Graded on the modified Davis scale:
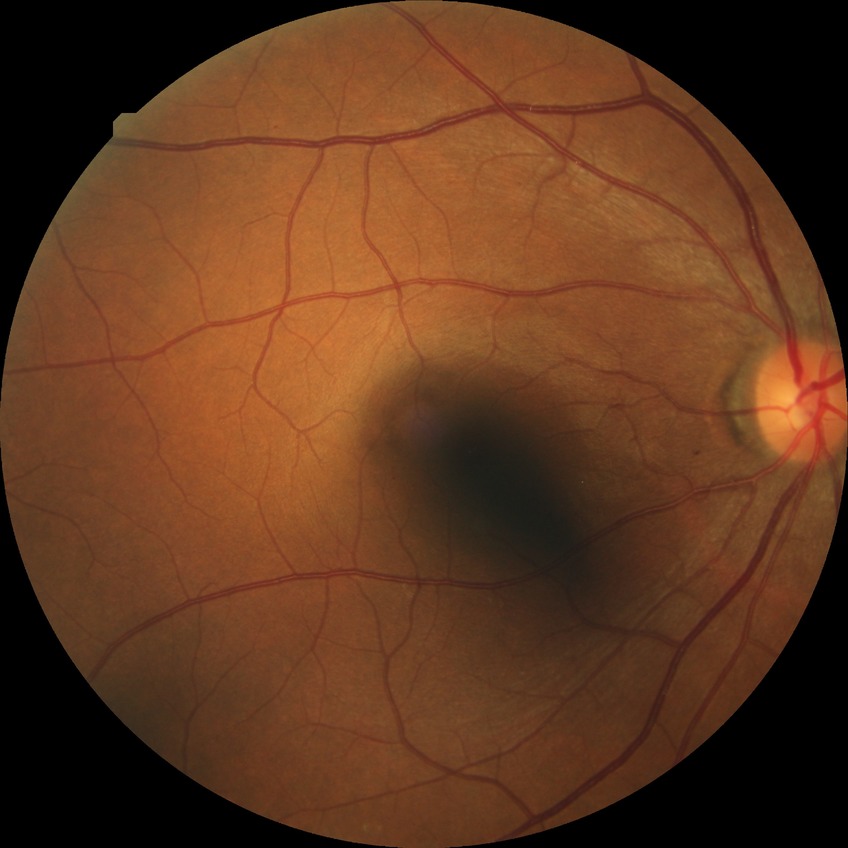

{
  "davis_grade": "simple diabetic retinopathy"
}